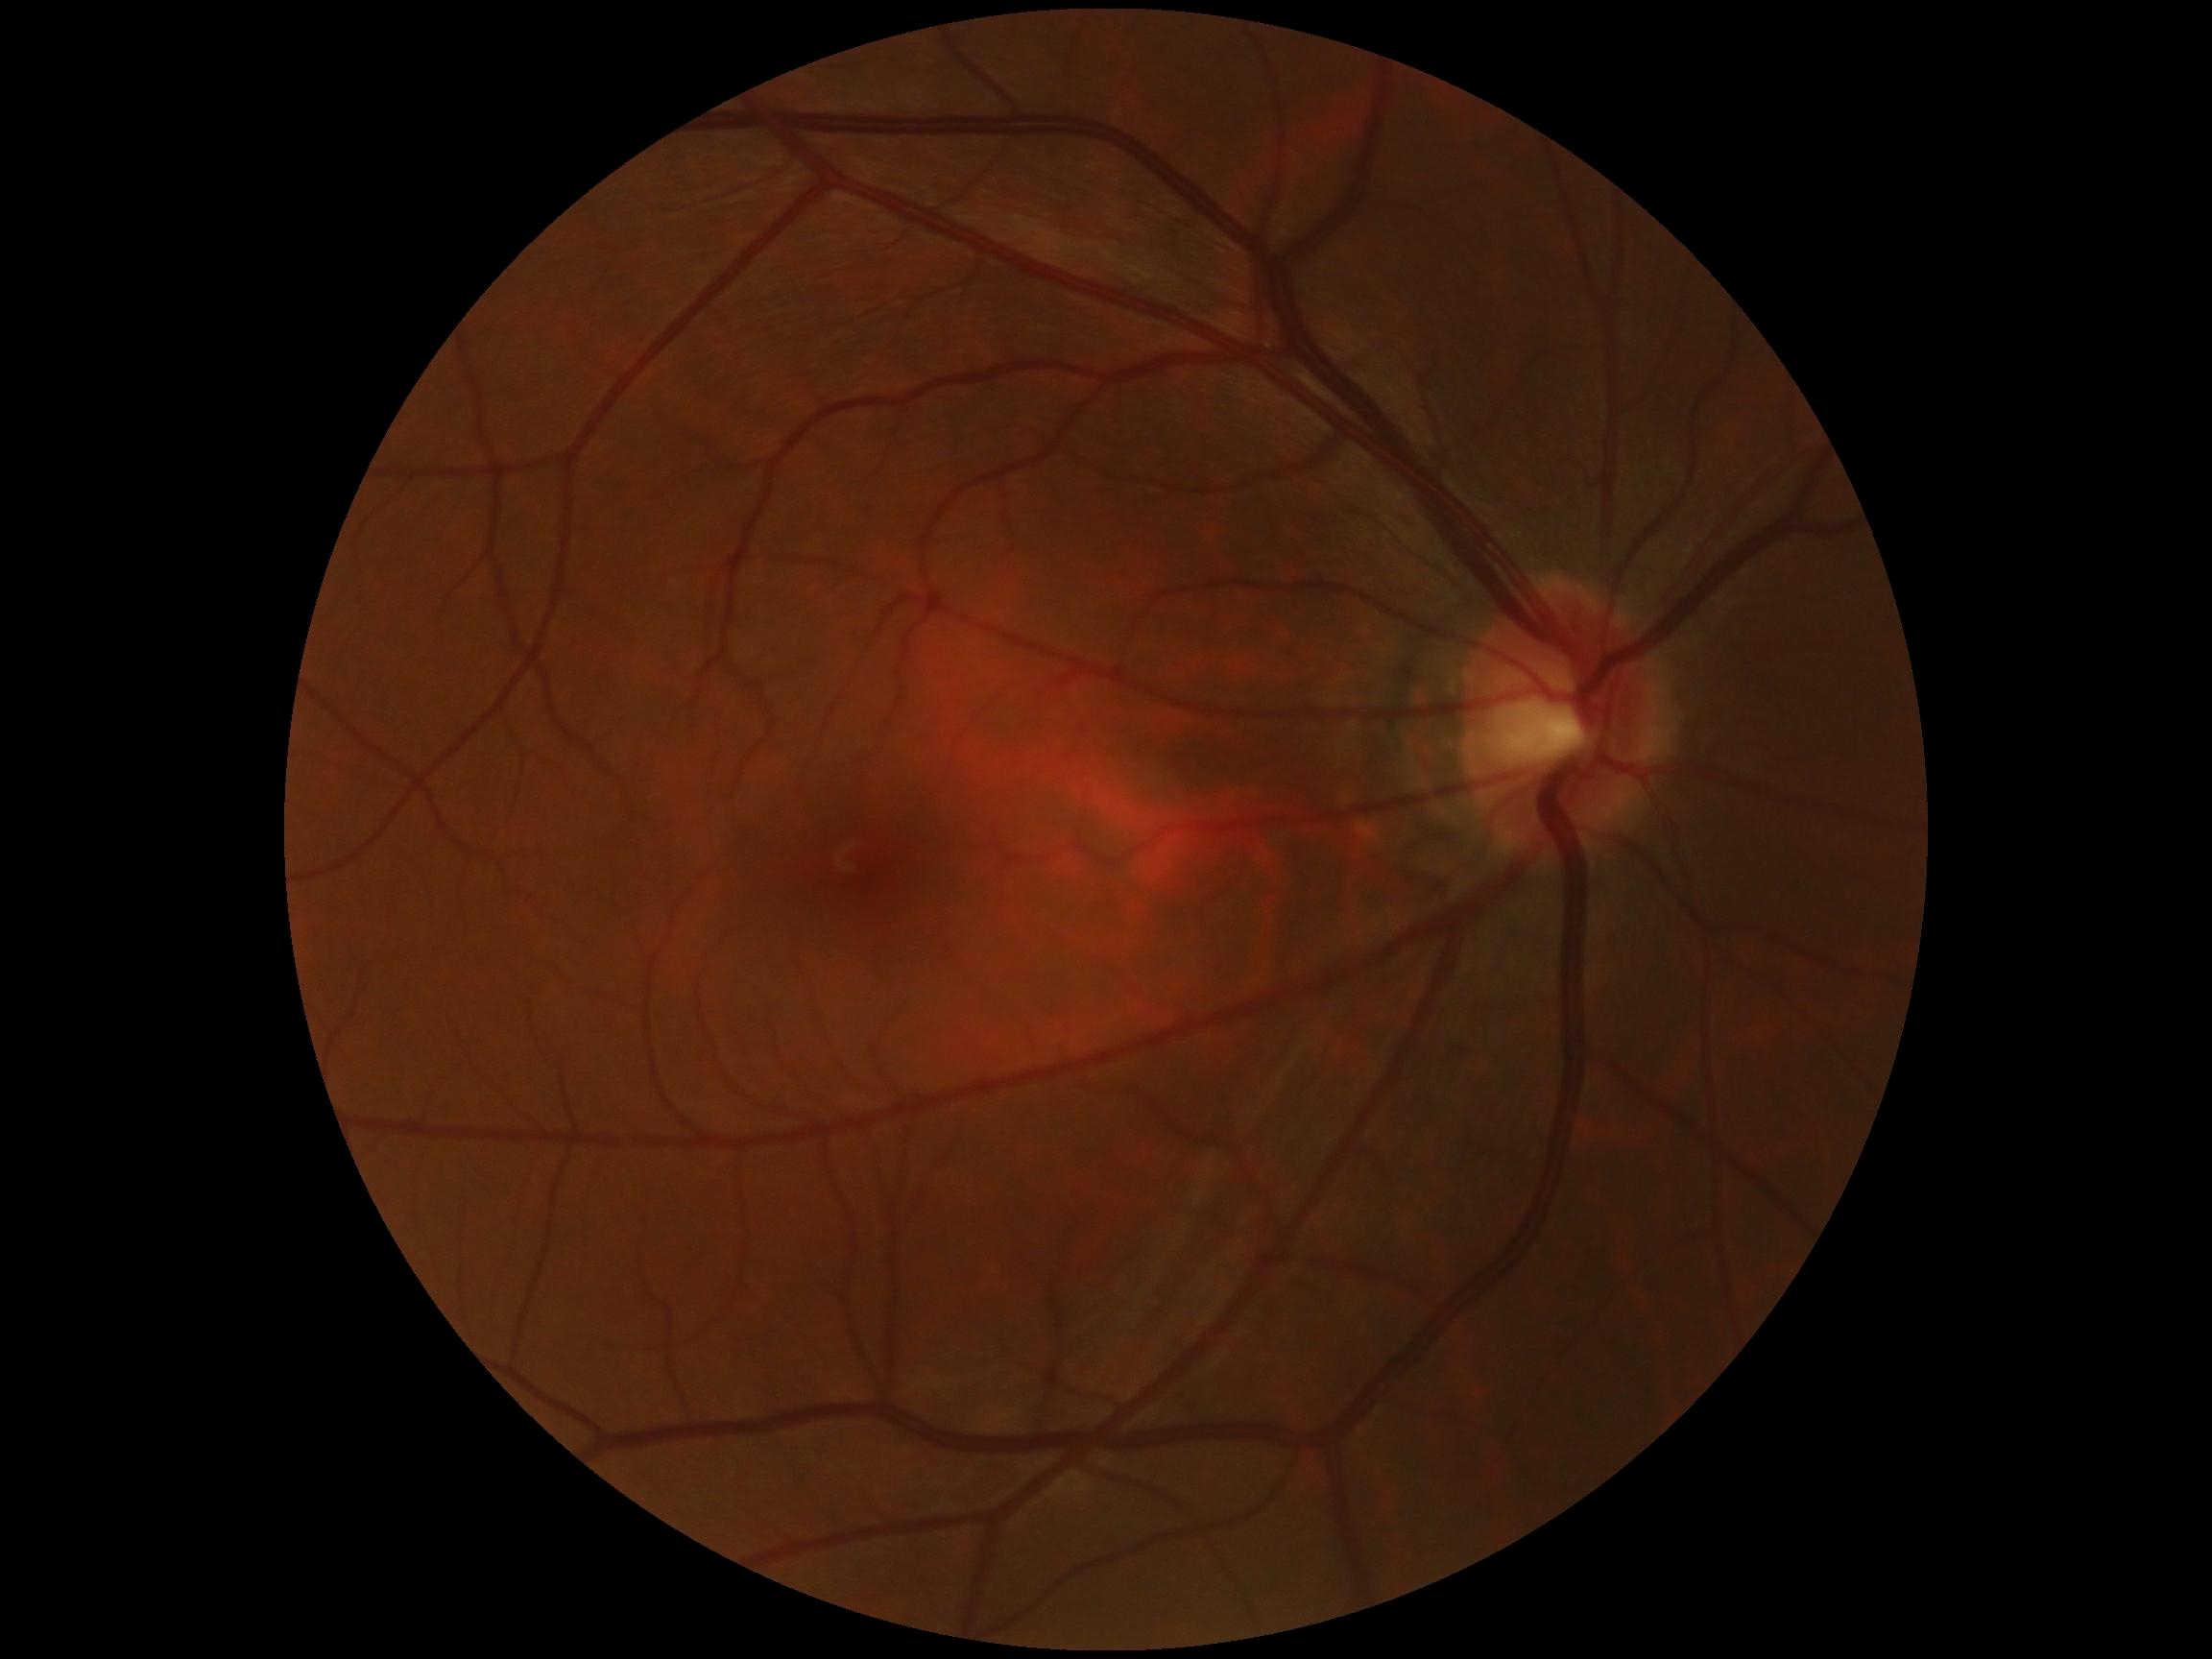 • DR grade: no apparent diabetic retinopathy (0)